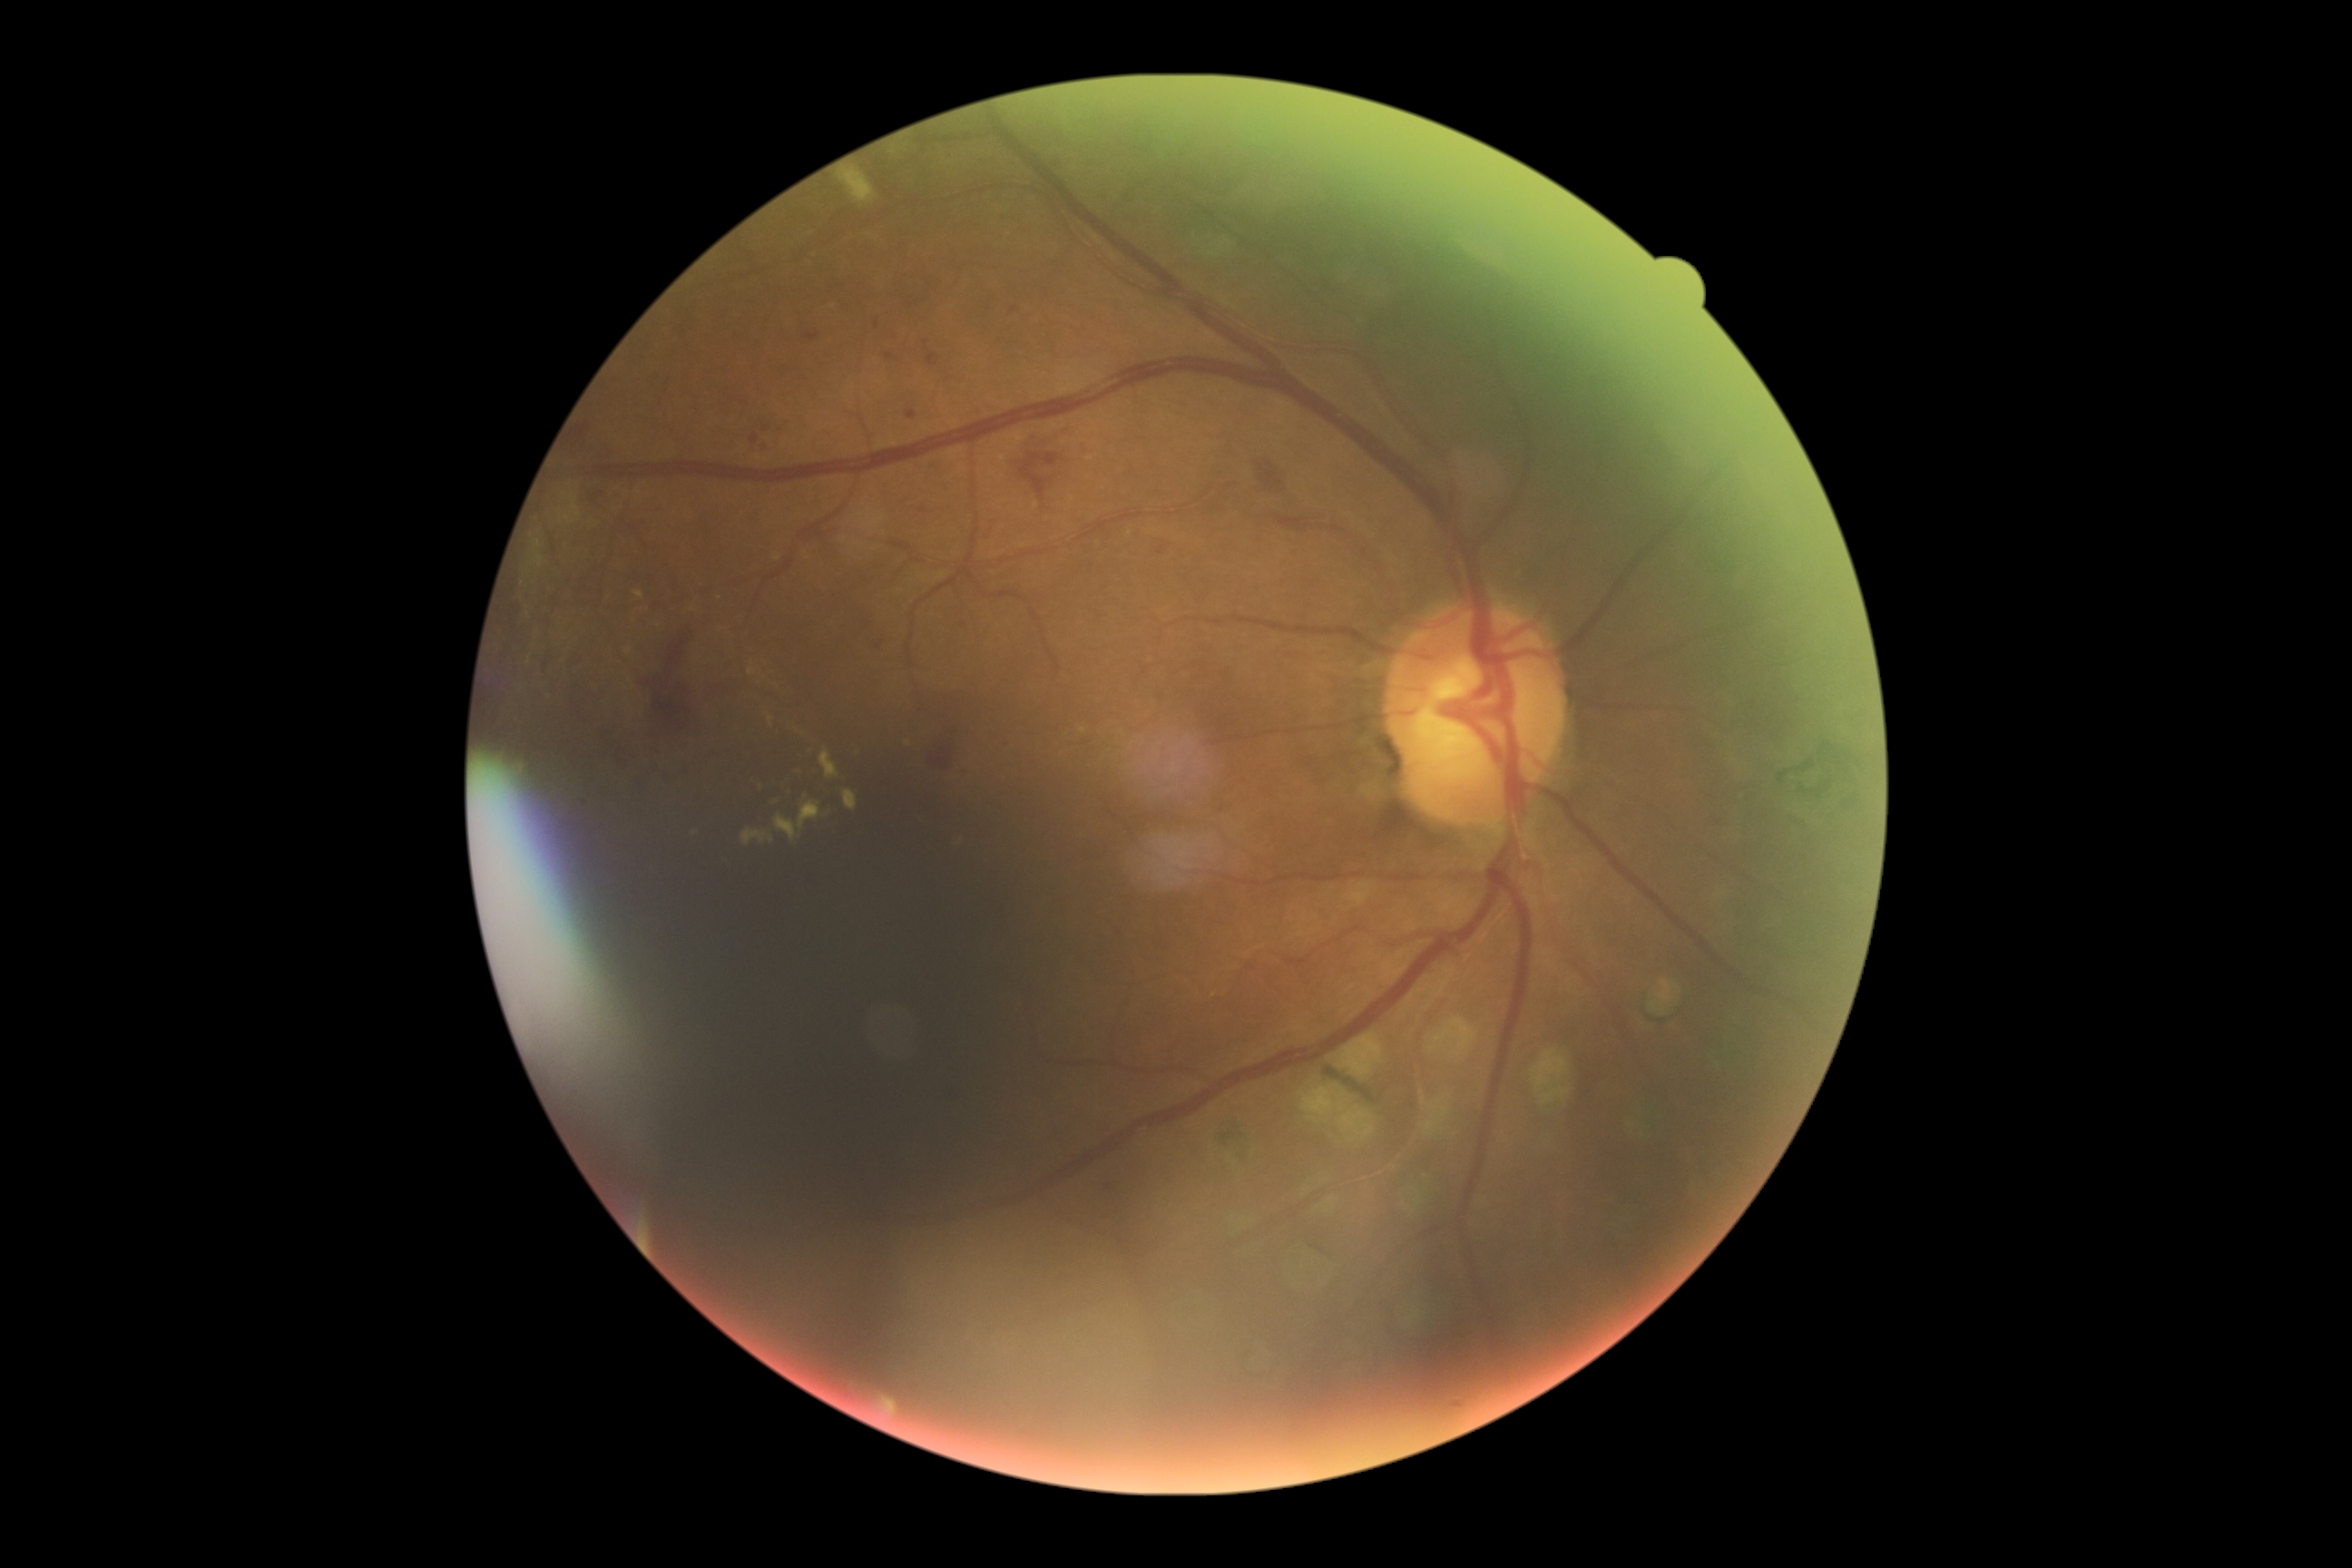
DR stage: 2/4.